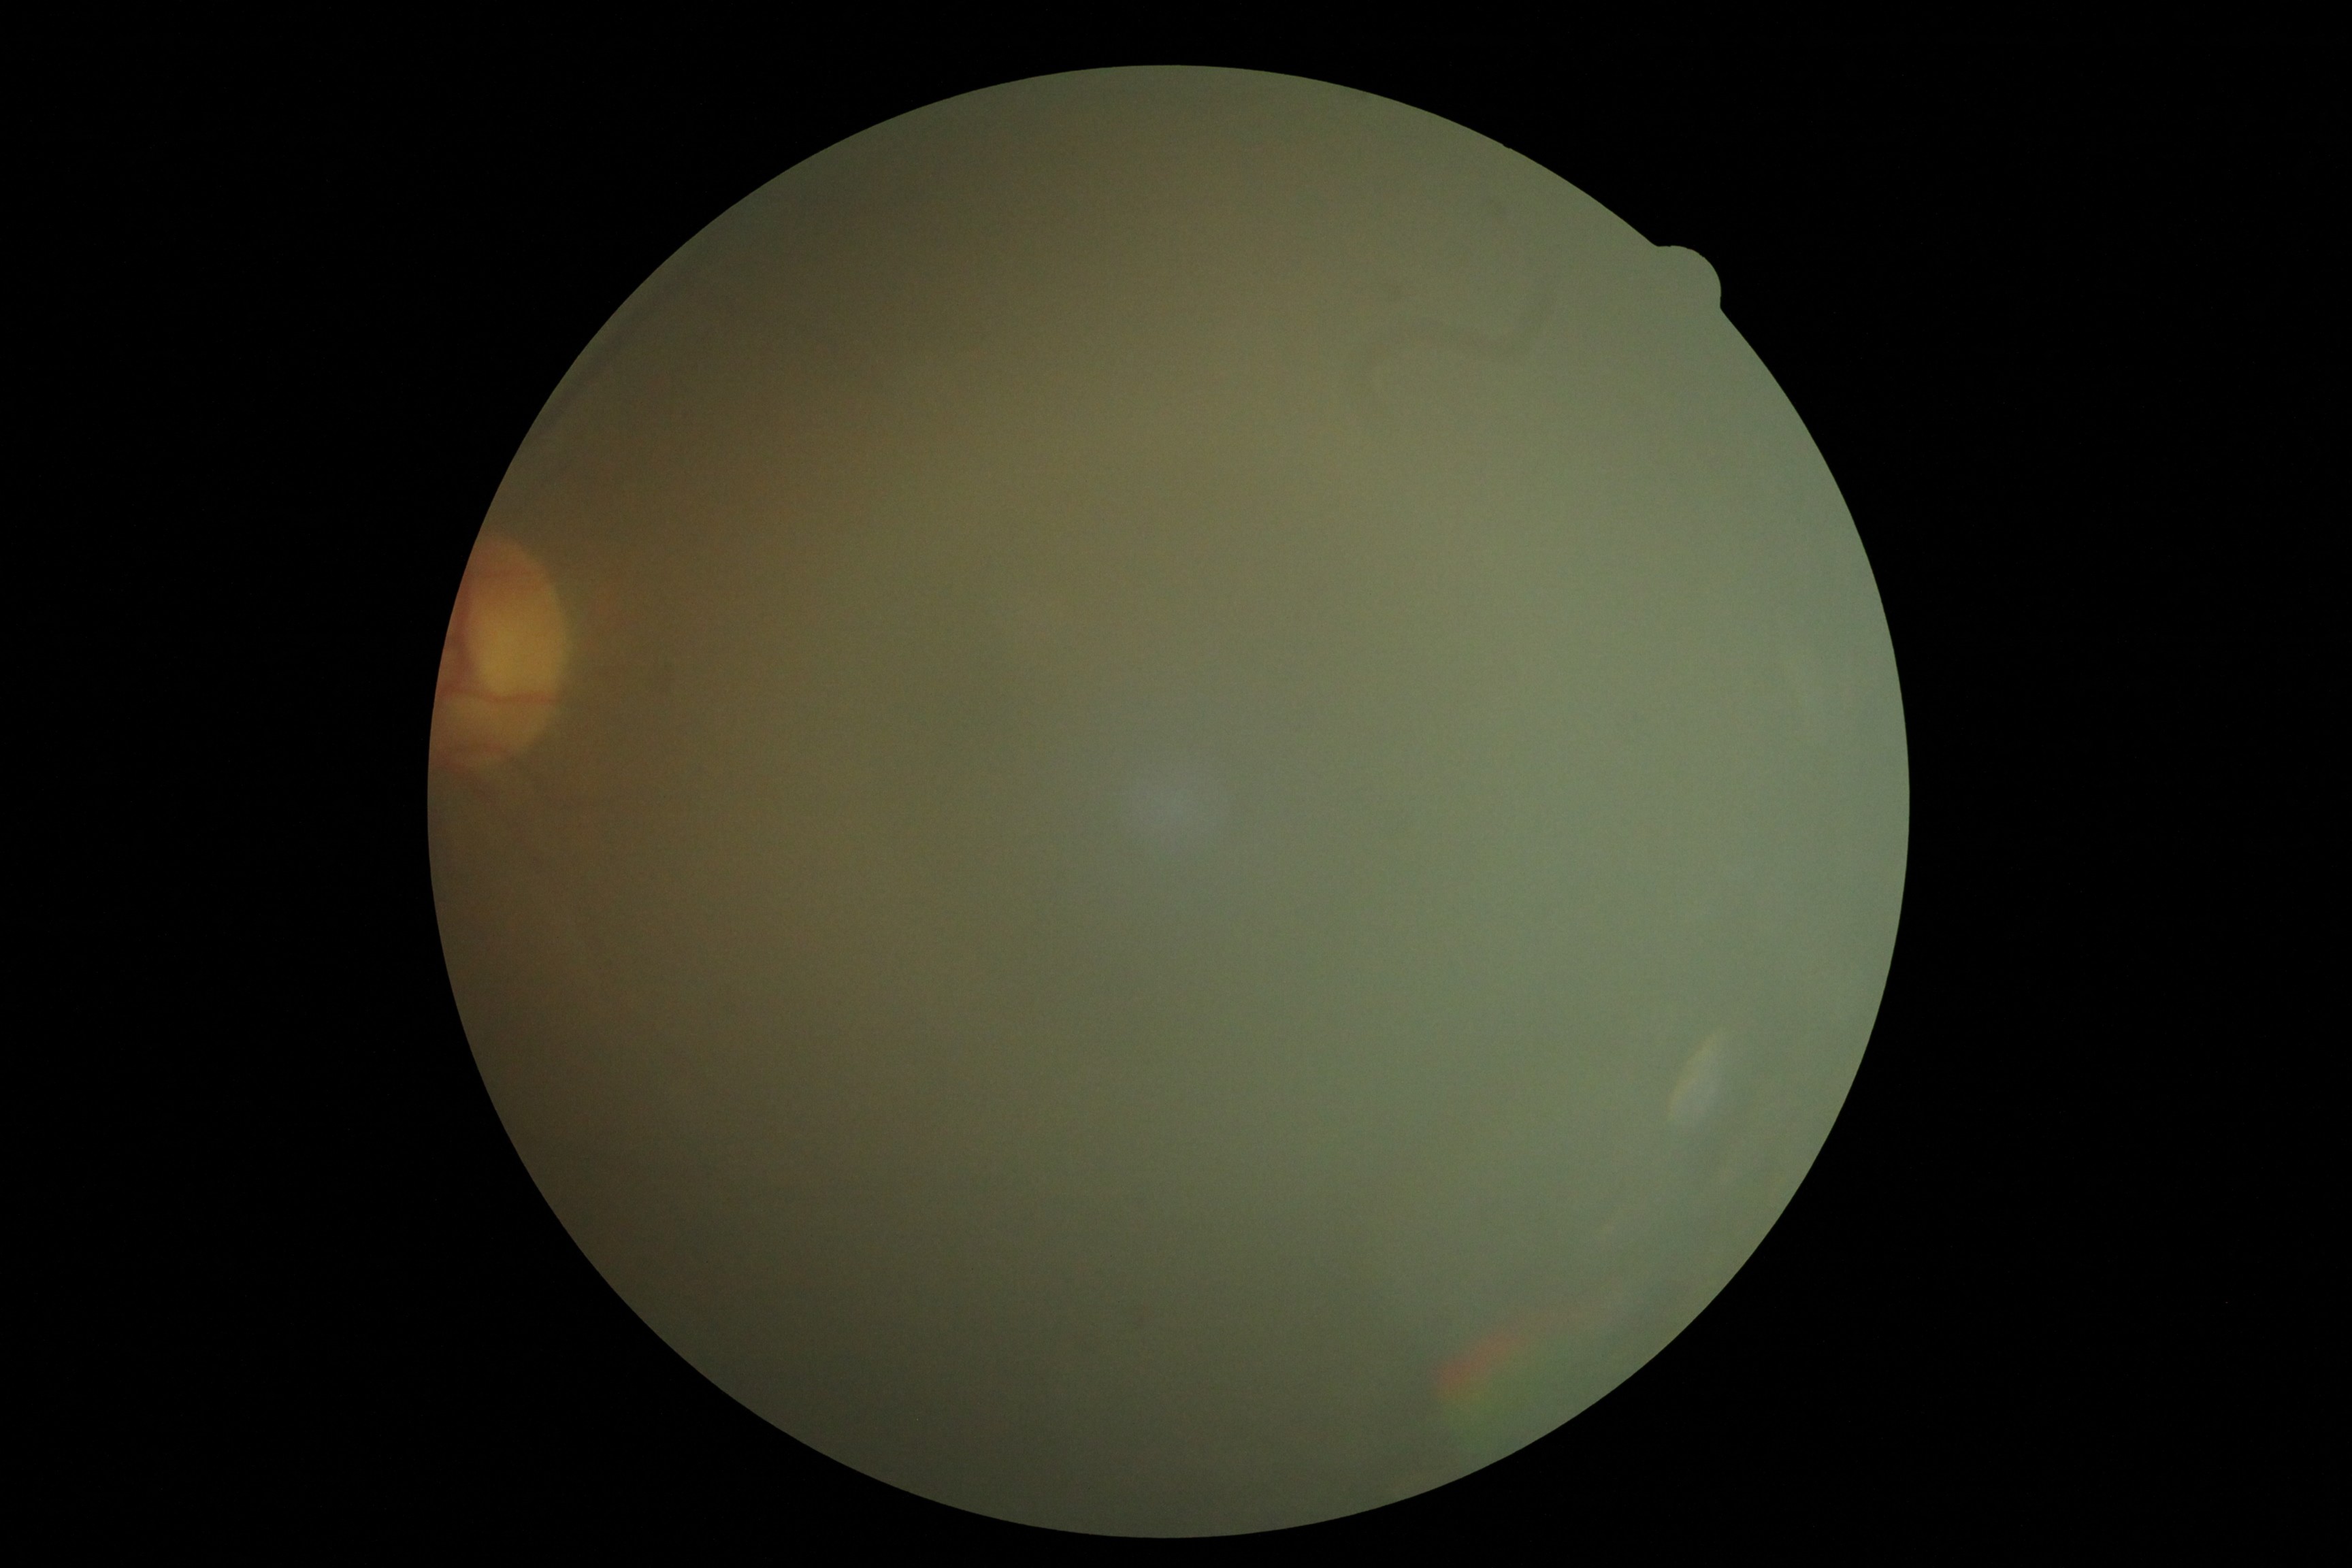 DR stage: ungradable due to poor image quality.